50-degree field of view; central posterior field; 2228 by 1652 pixels; pupil-dilated
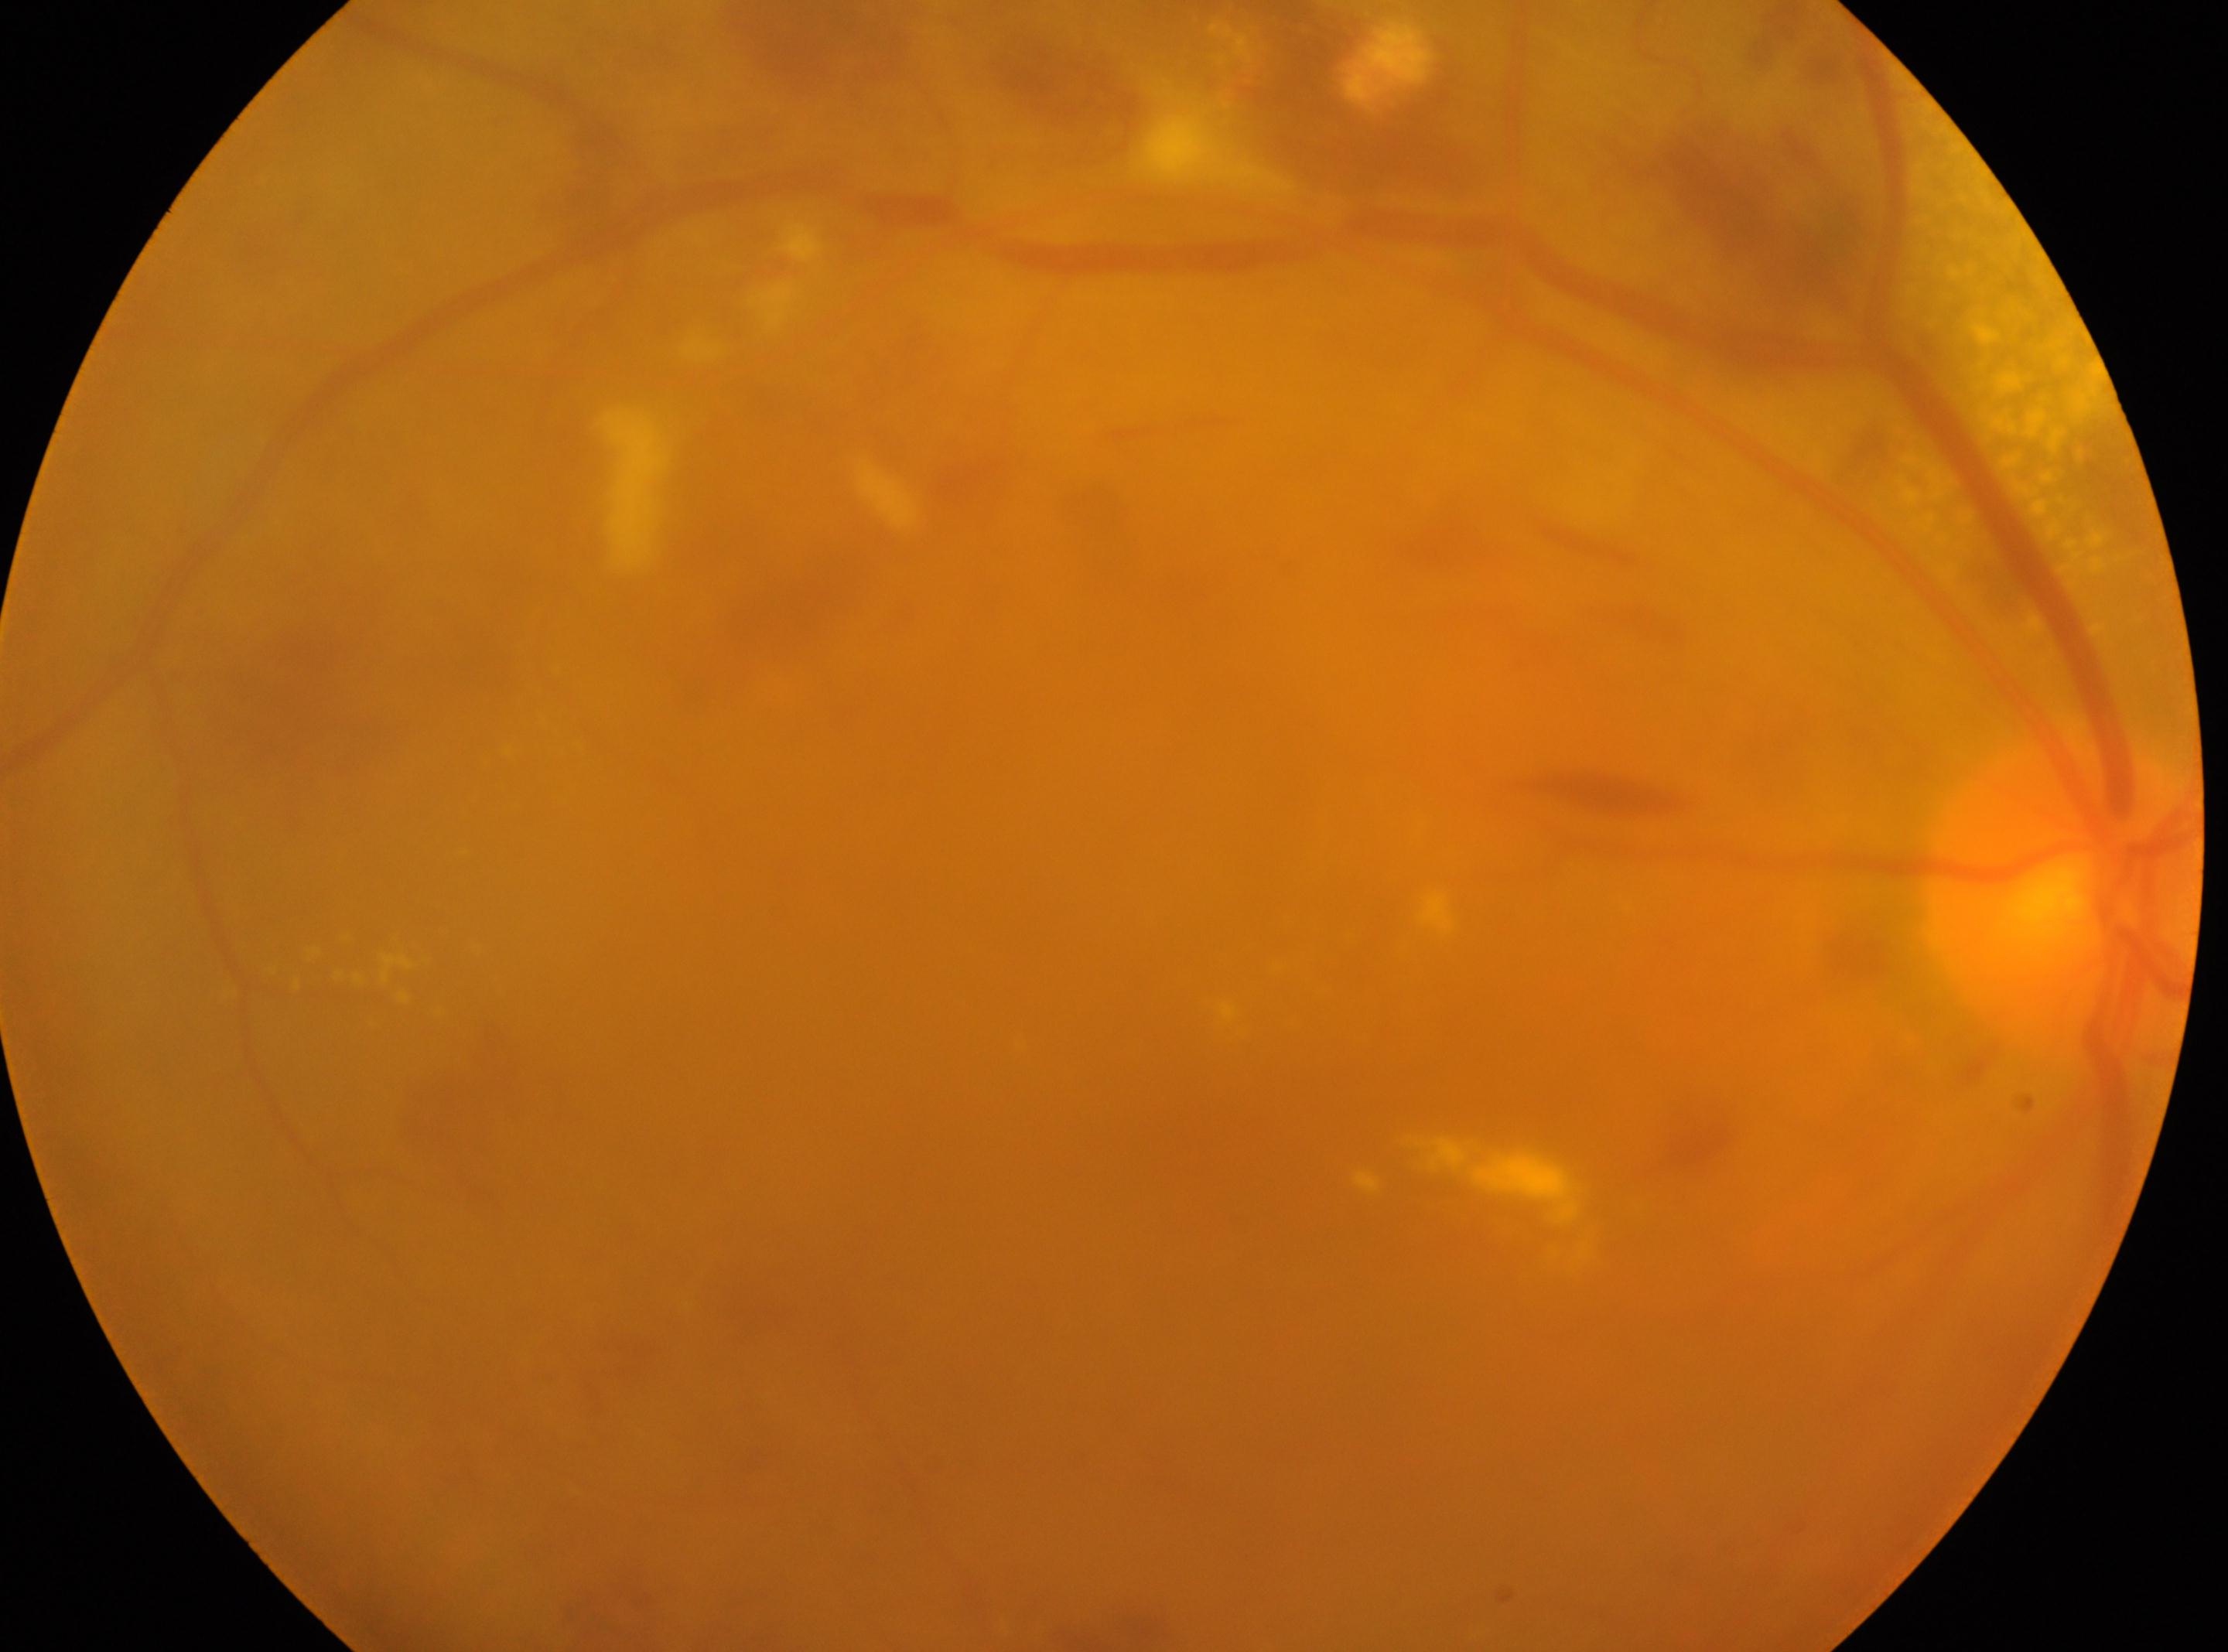 eye: OD | fovea centralis: (x=1191, y=1134) | the optic disc: (x=2061, y=896) | DR grade: 2 (moderate NPDR).